1659x2212px
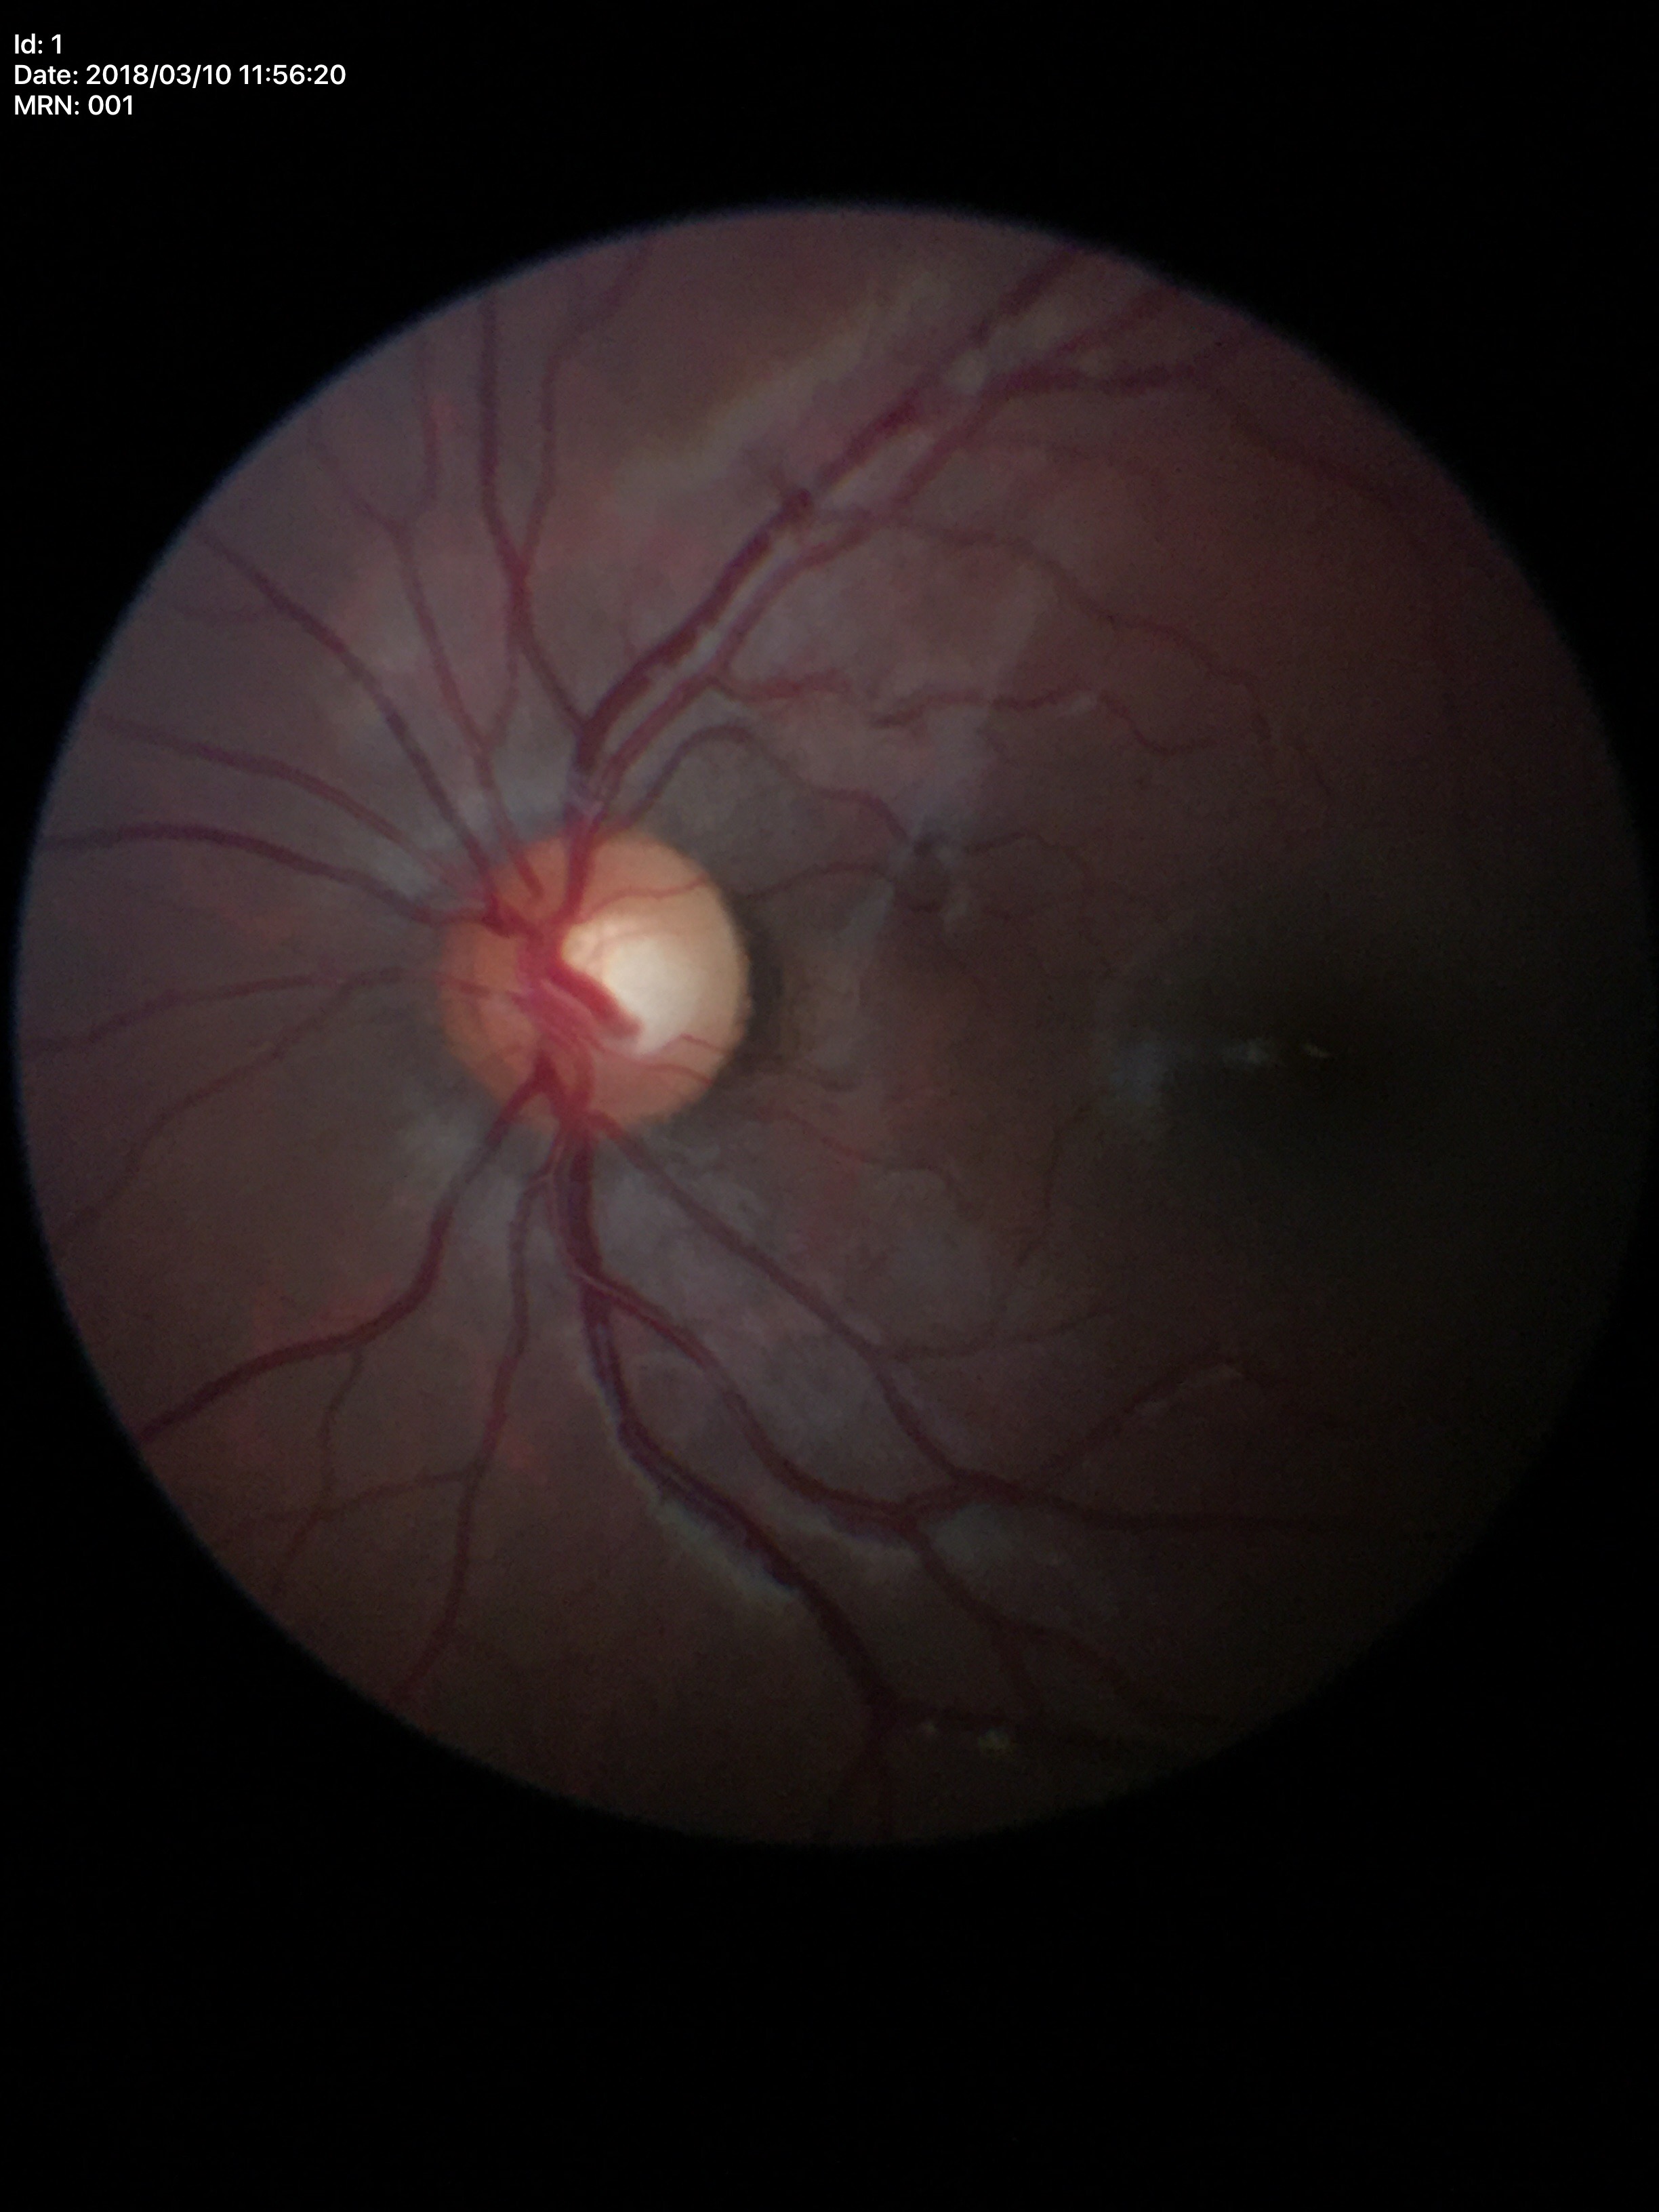 vertical C/D ratio (VCDR)=0.50 | Glaucoma screening impression=no suspicious findings (all 5 graders called normal)